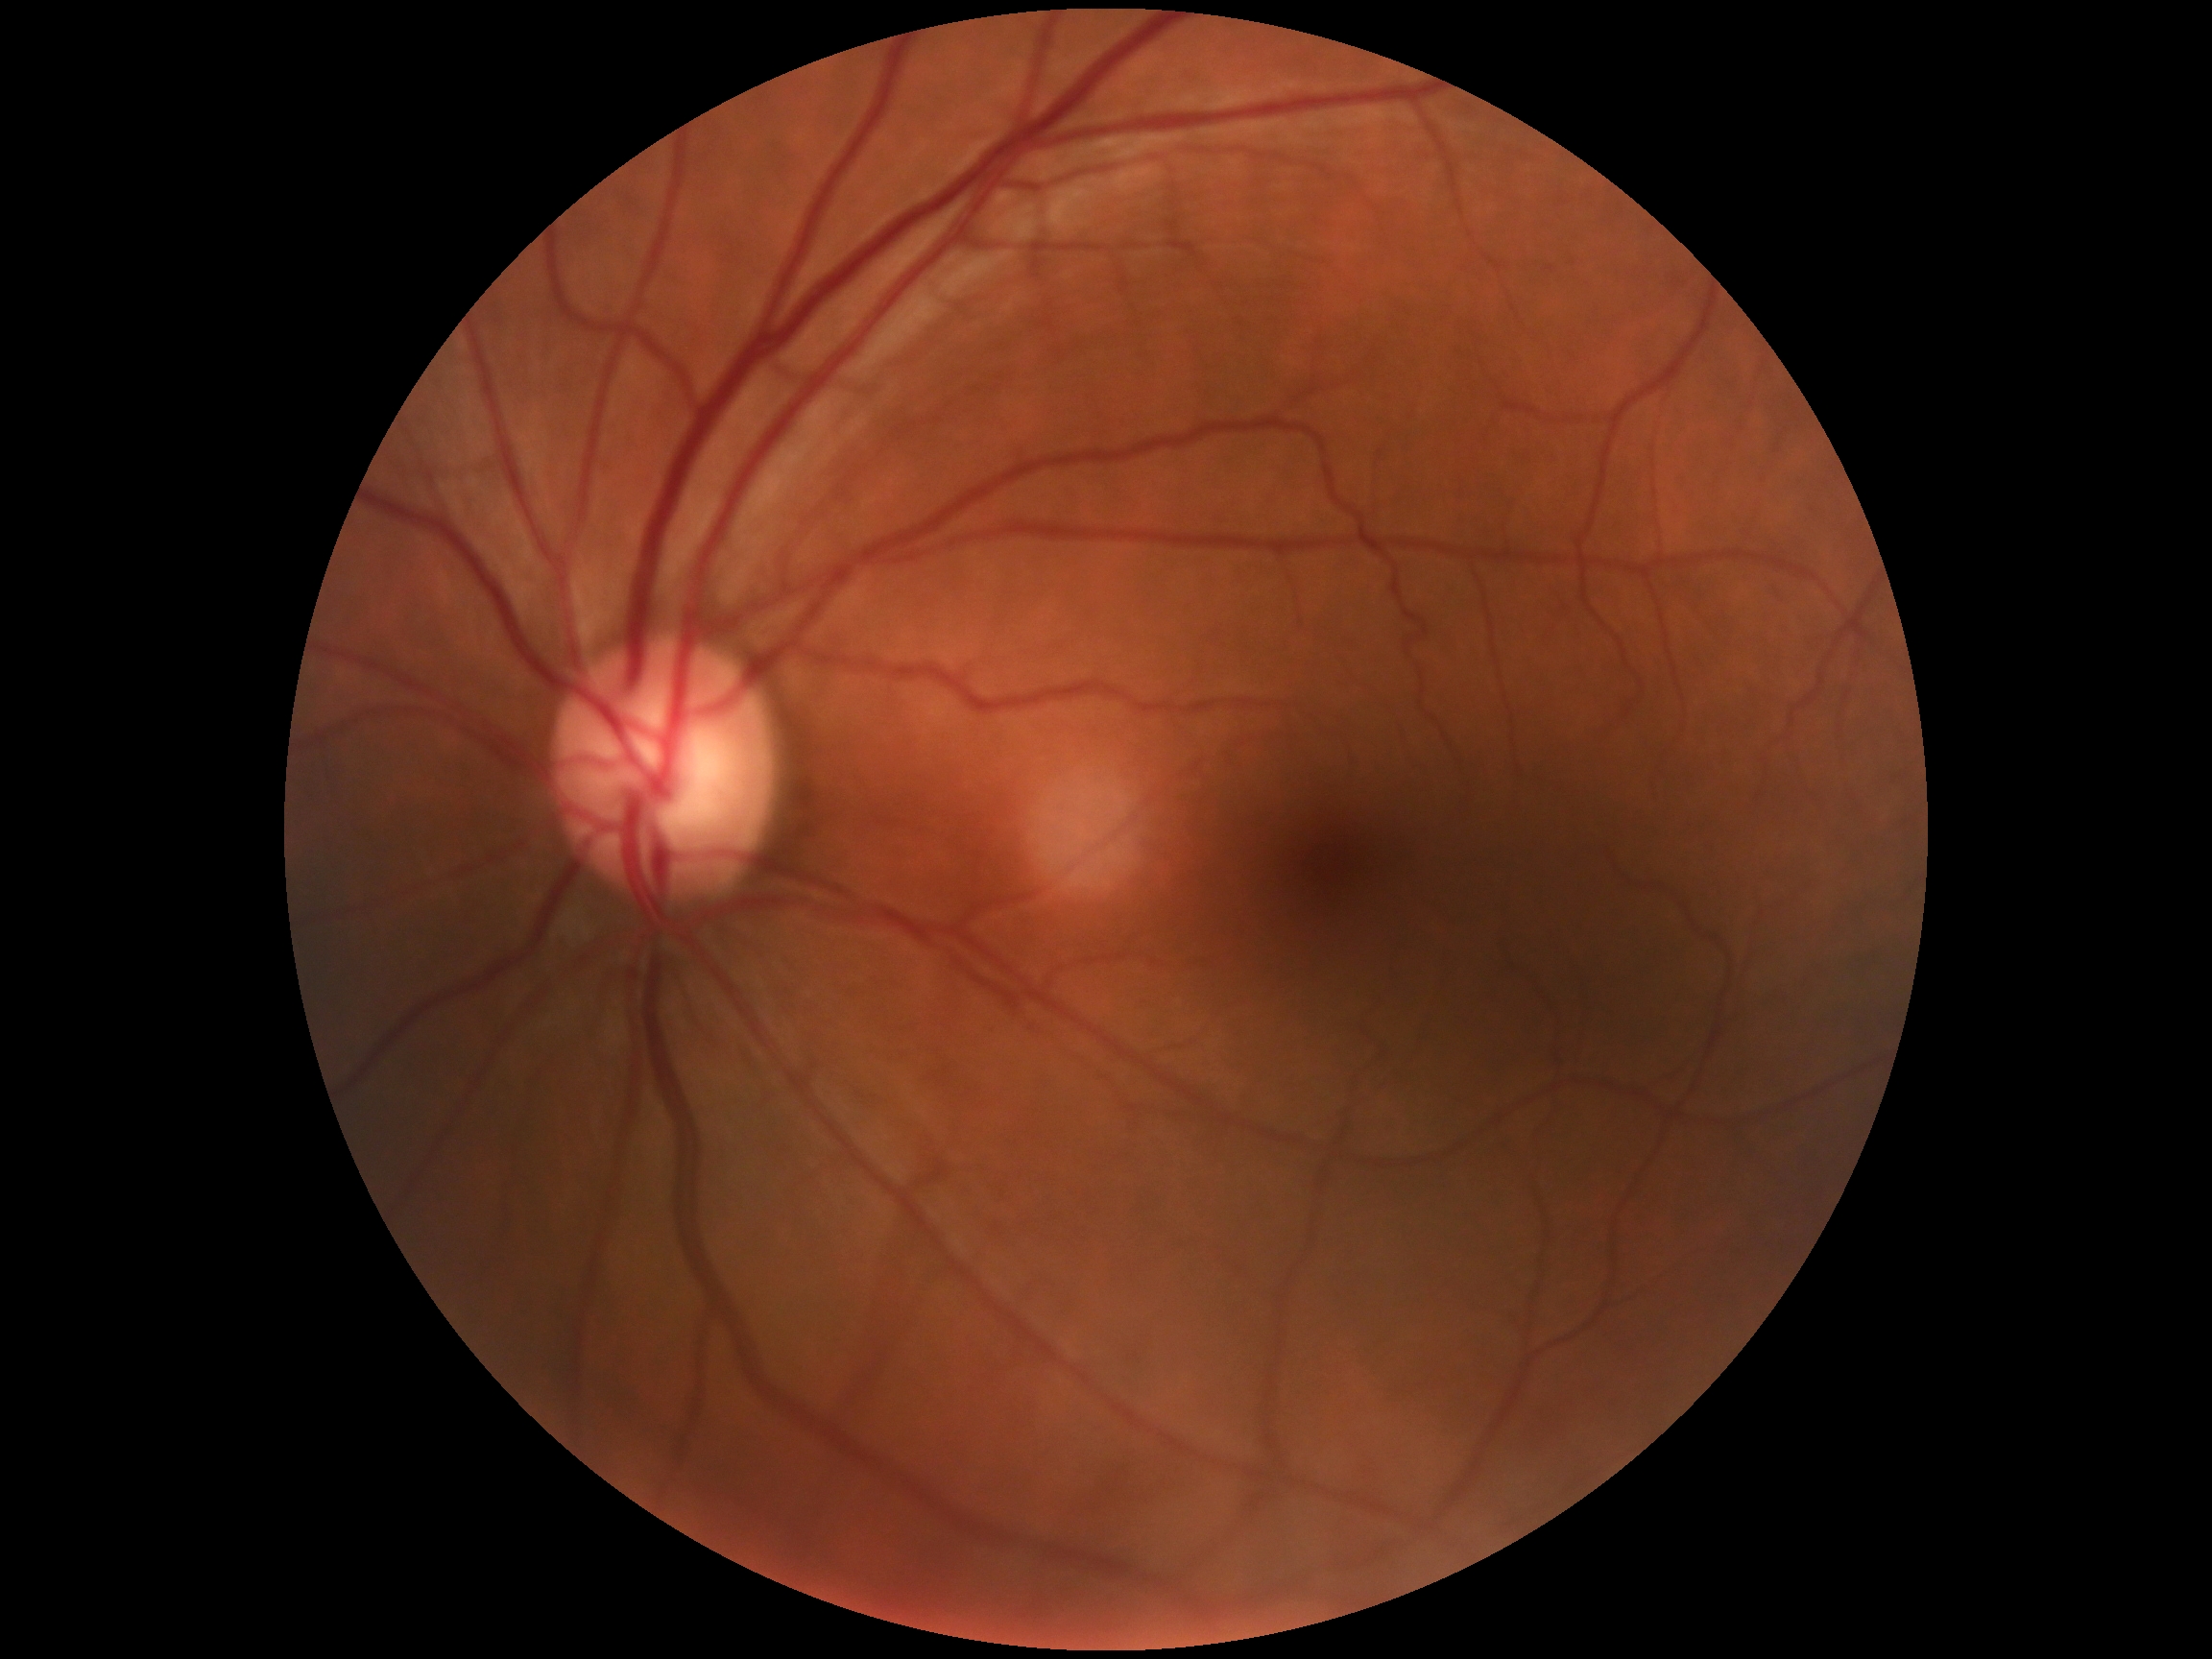
DR stage: grade 0.